45-degree field of view: 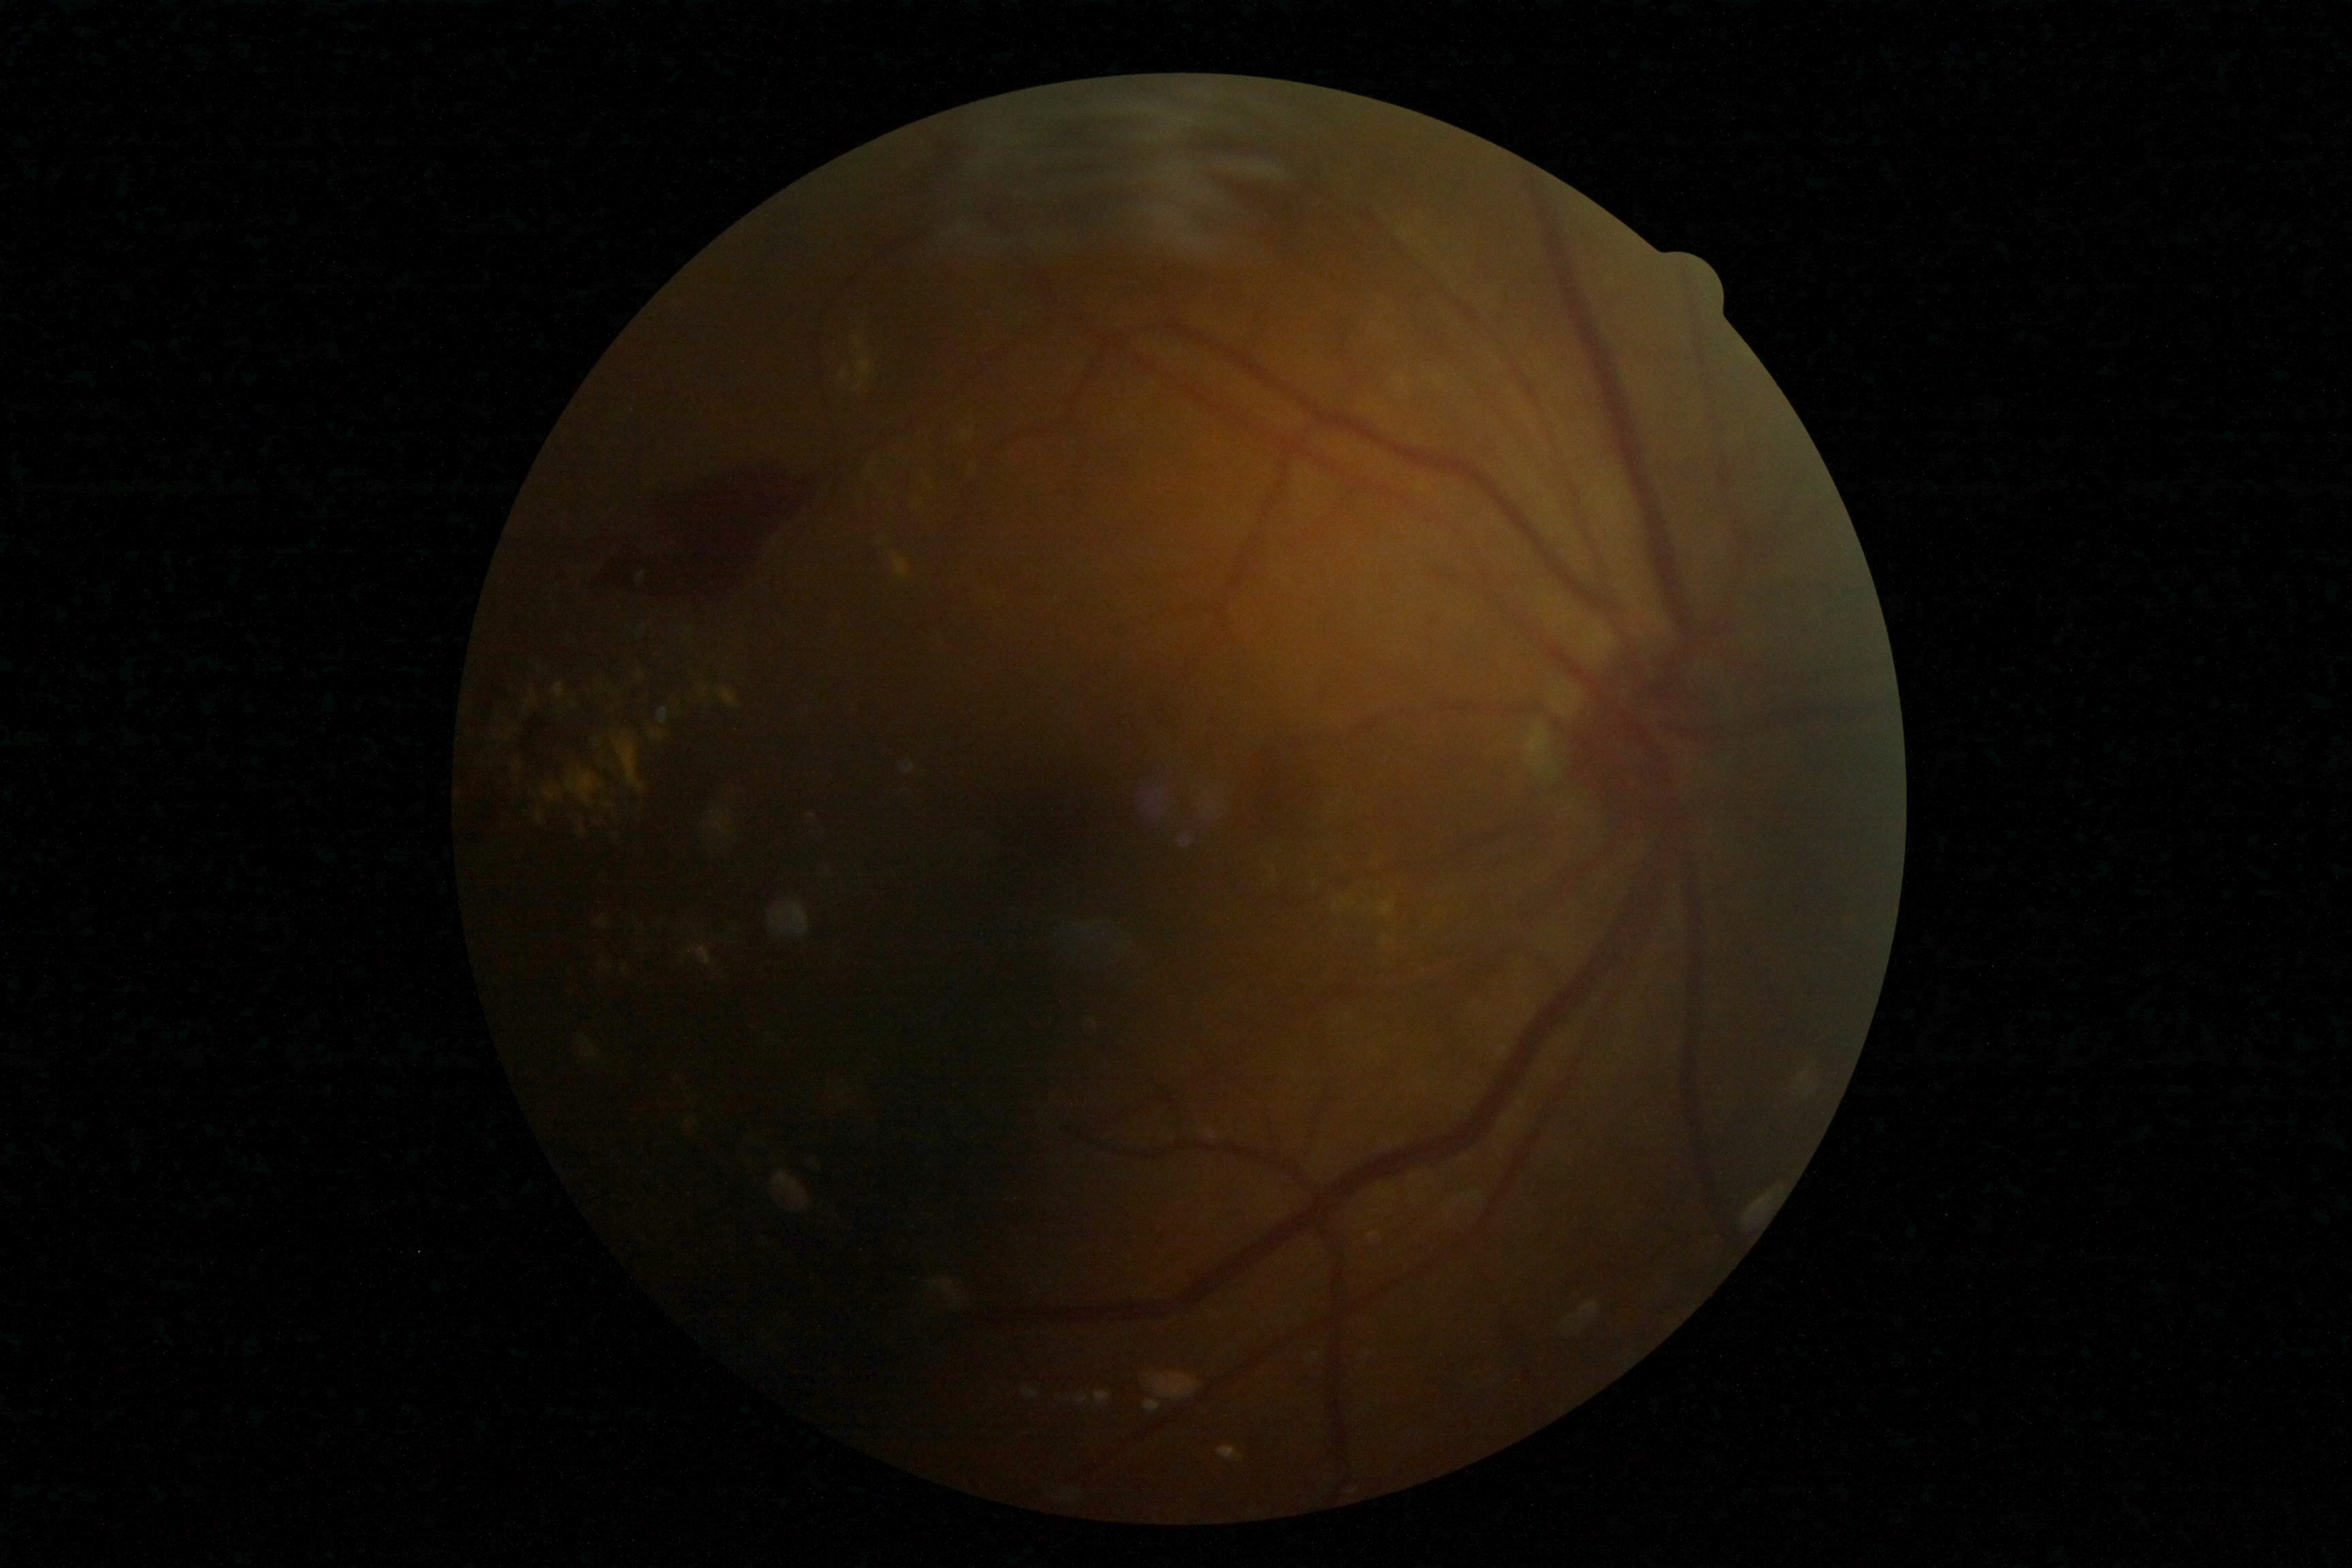 DR grade = 4/4 — neovascularization and/or vitreous/pre-retinal hemorrhage.